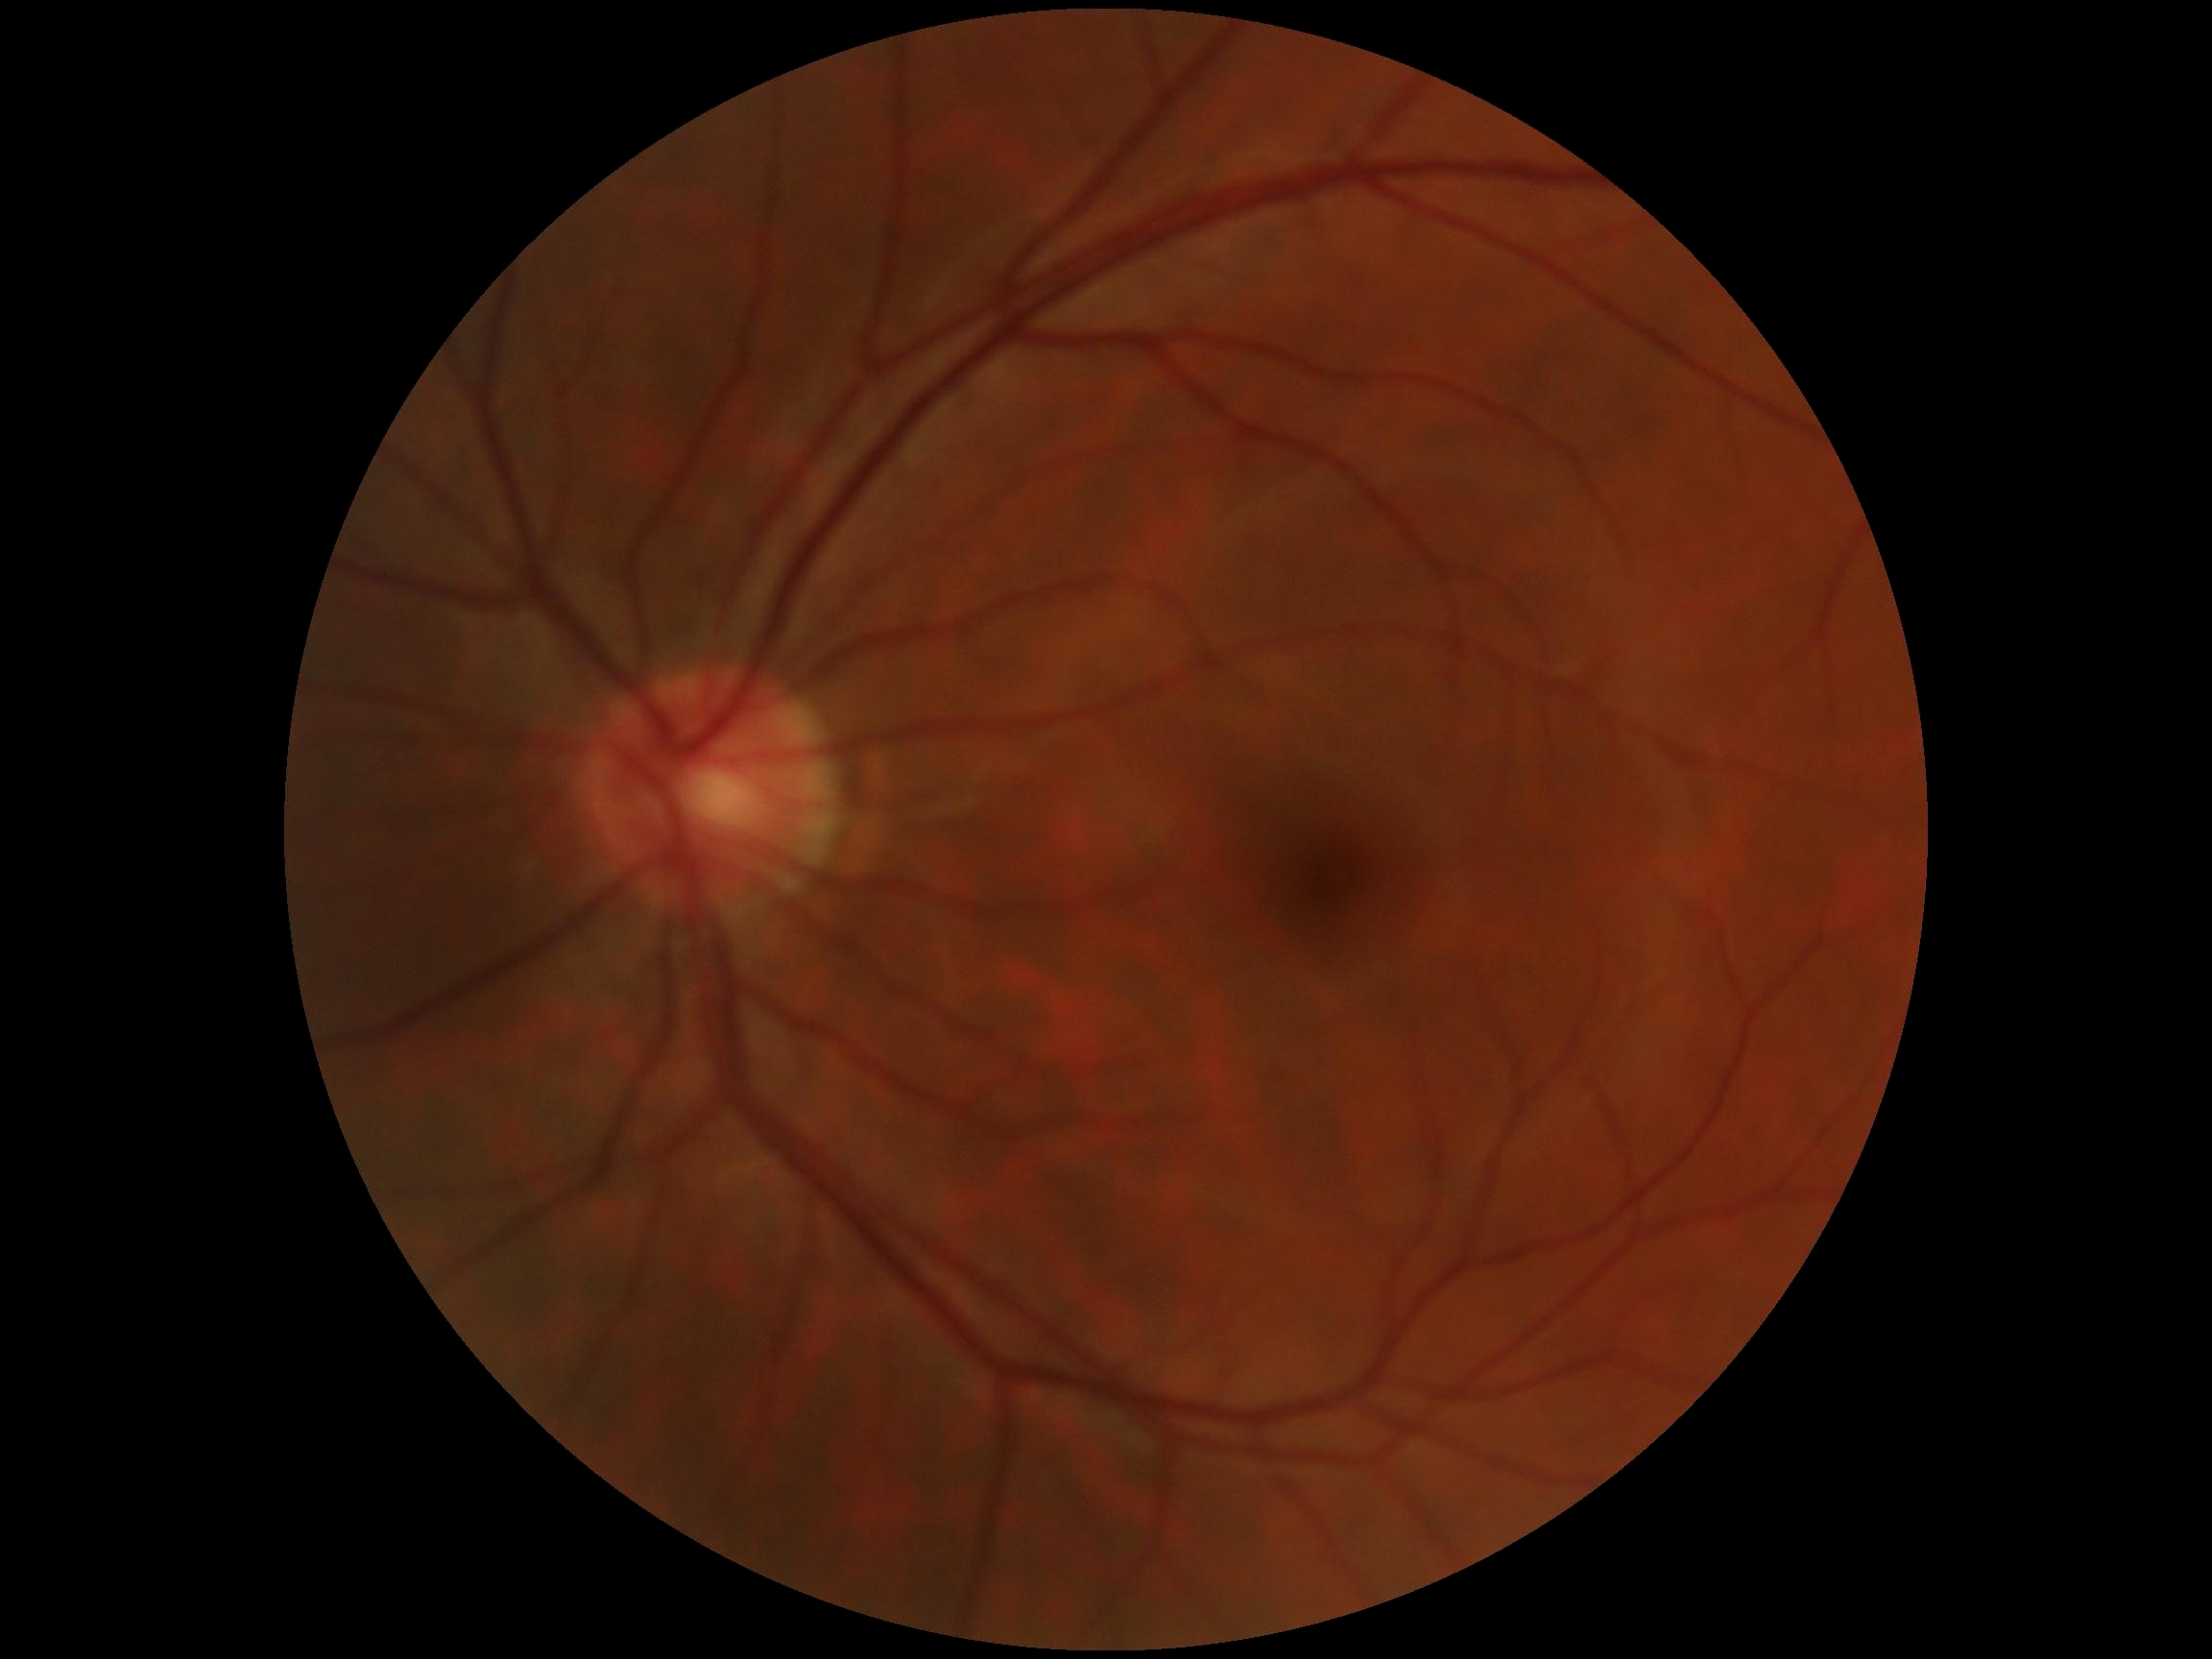
DR = grade 0 (no apparent retinopathy).